CFP, 45° FOV — 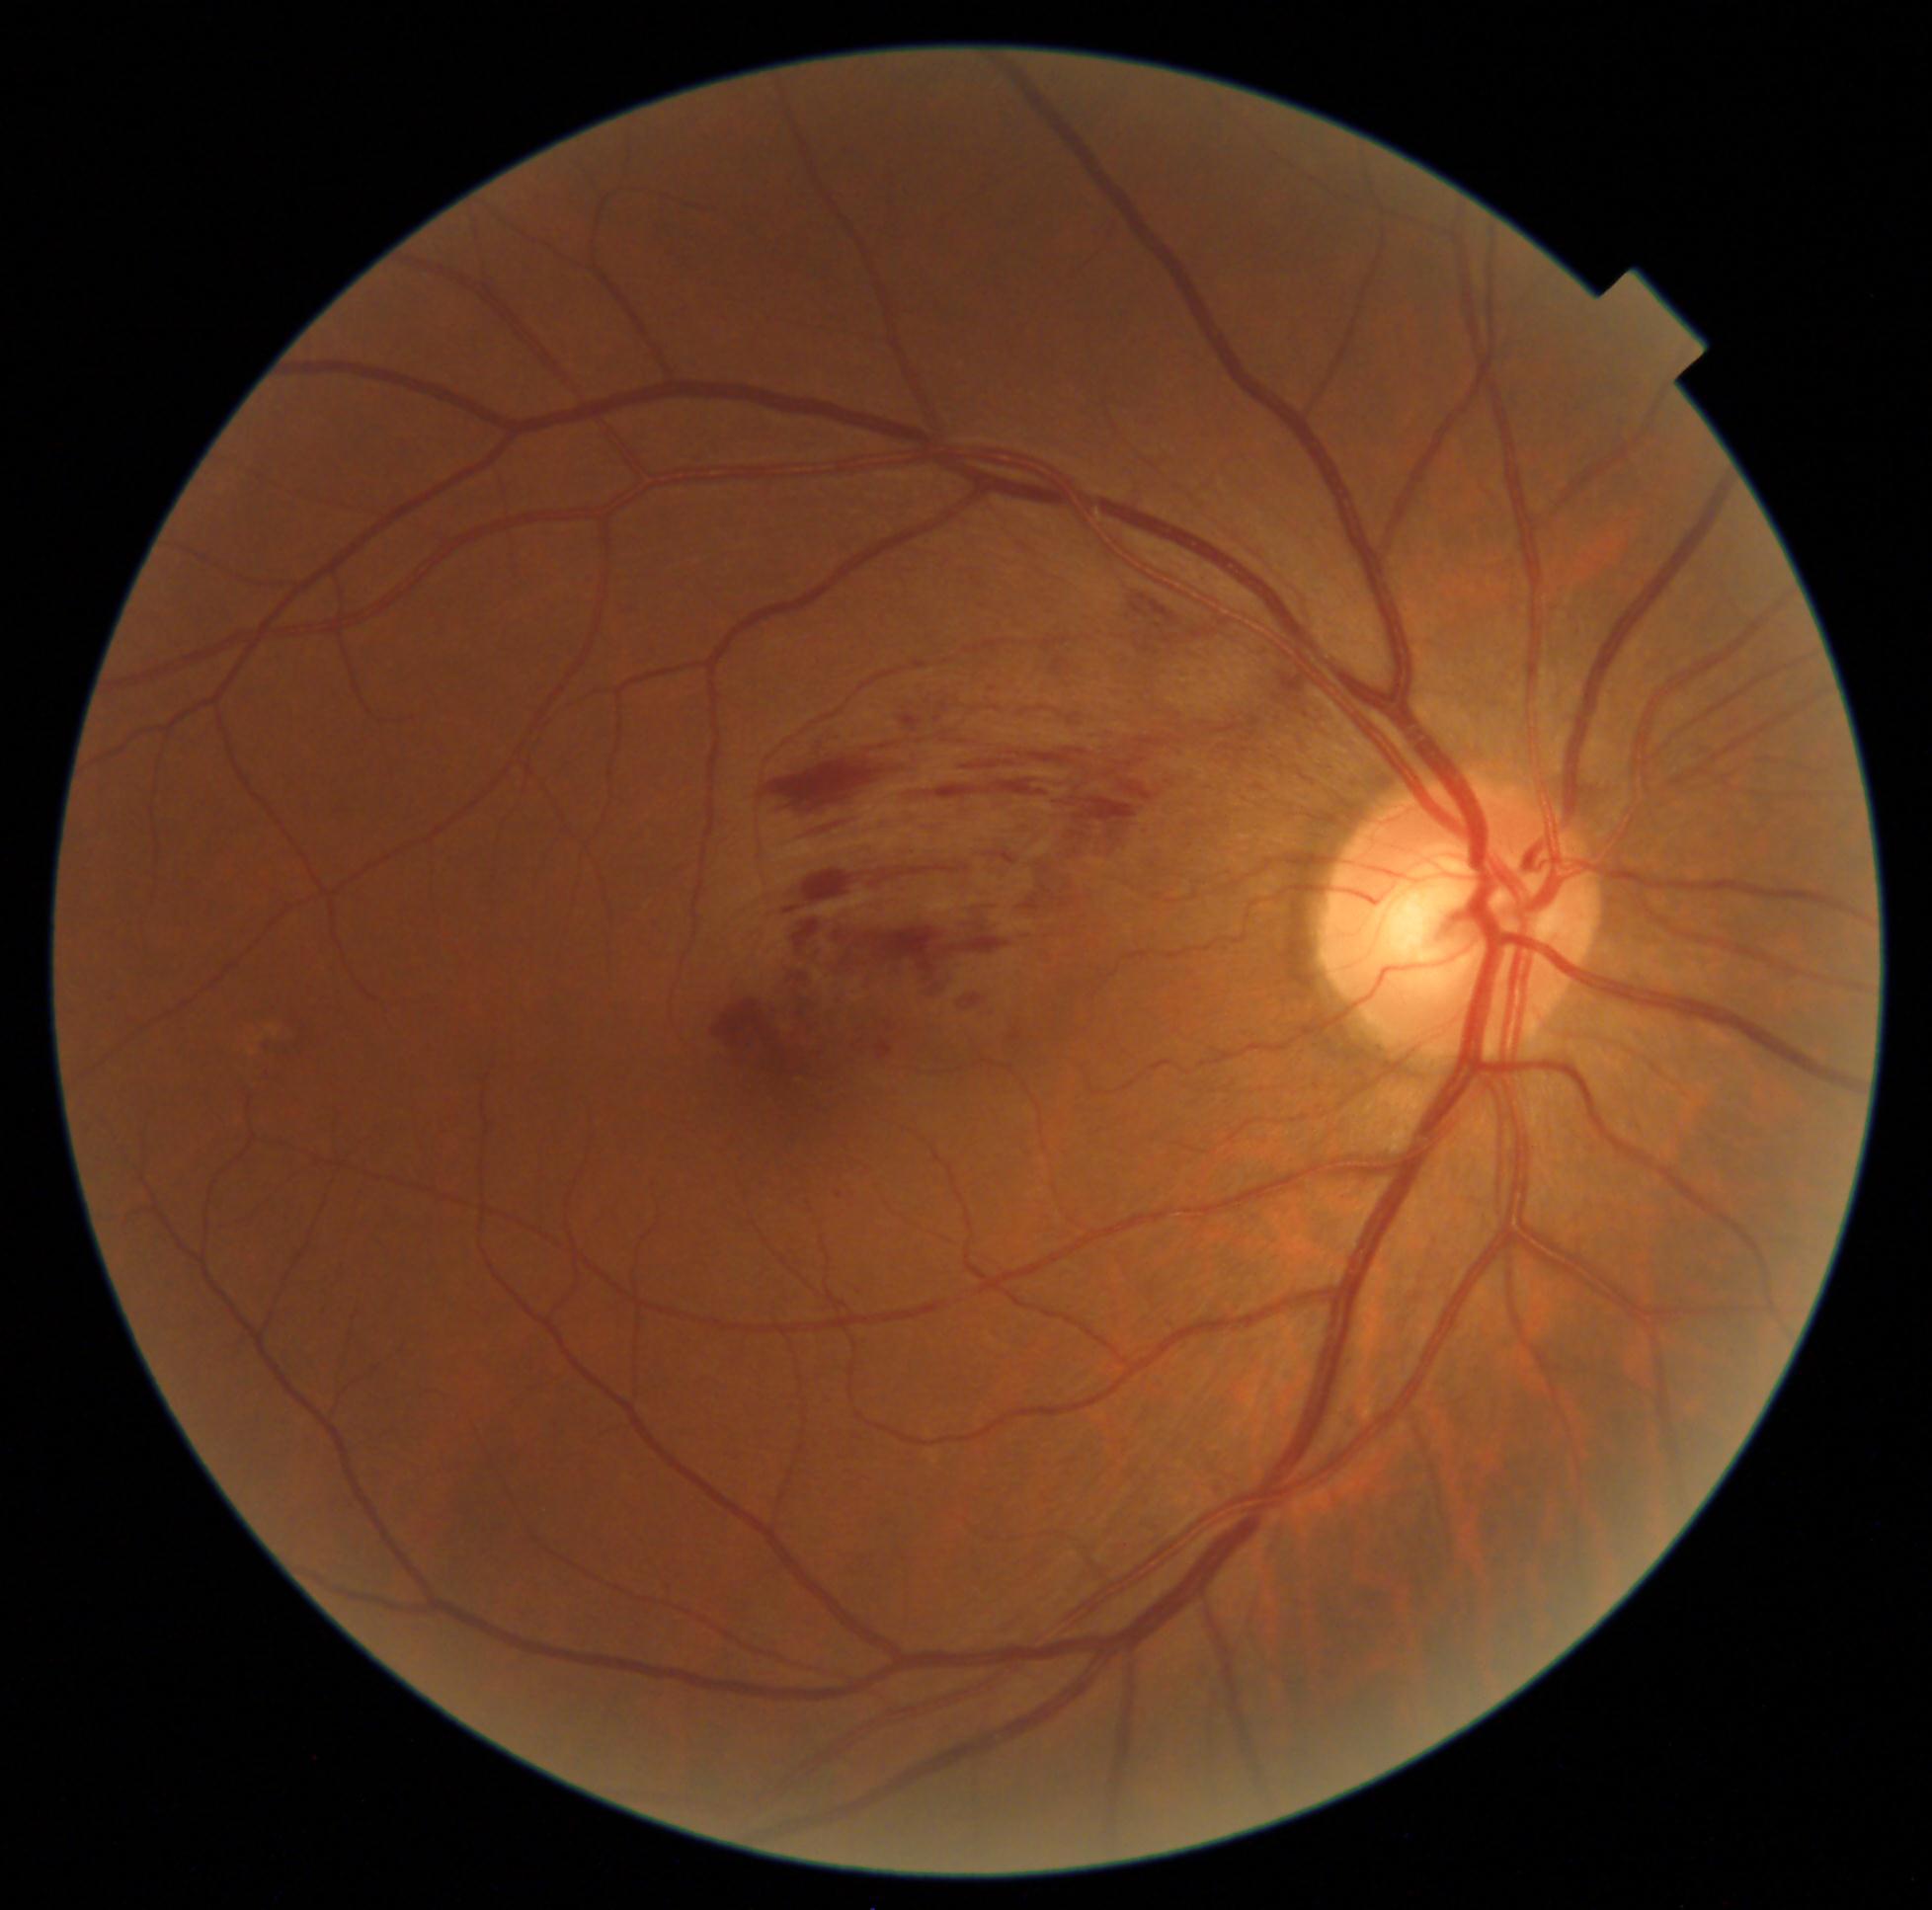

DR stage is grade 2.